1725x1721px:
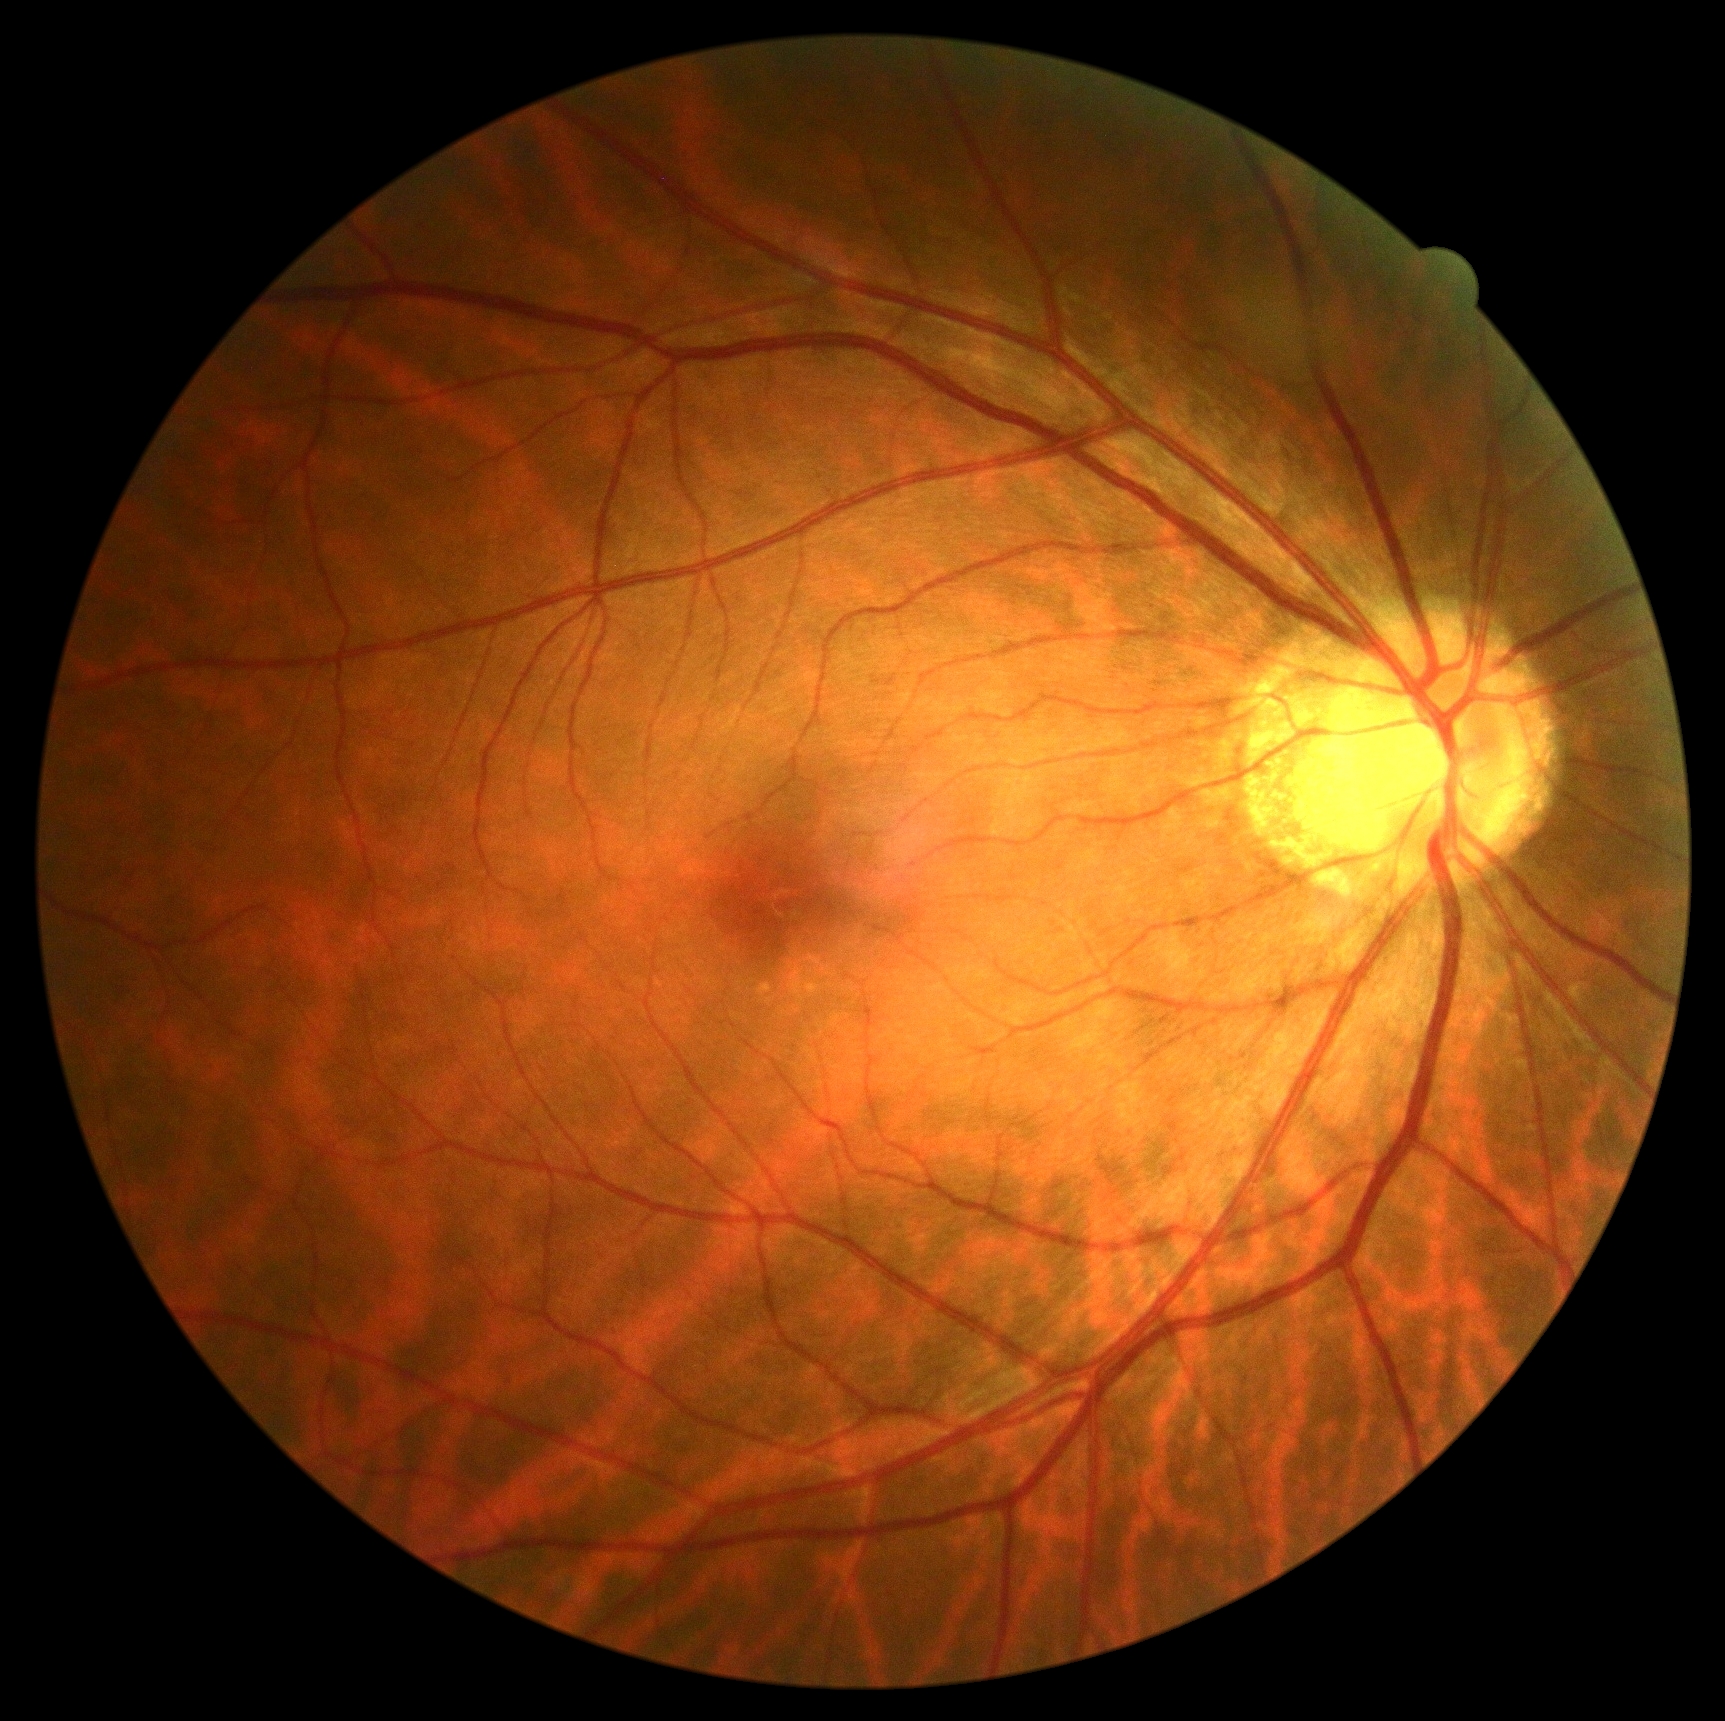
DR stage is grade 0.